Infant wide-field retinal image; 130° field of view (Clarity RetCam 3): 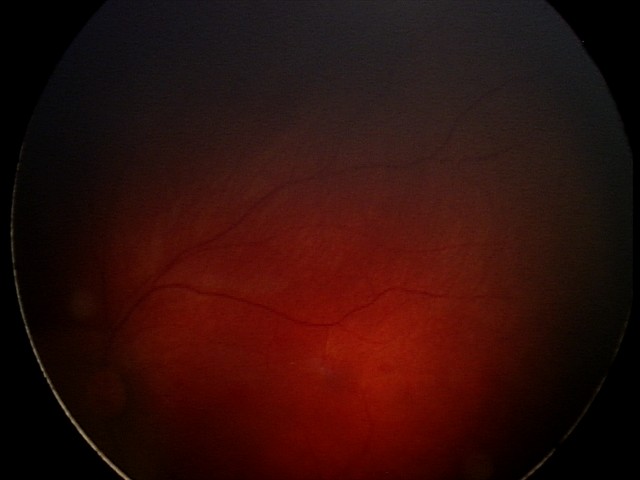
Impression = retinal hemorrhages.